1932x1916:
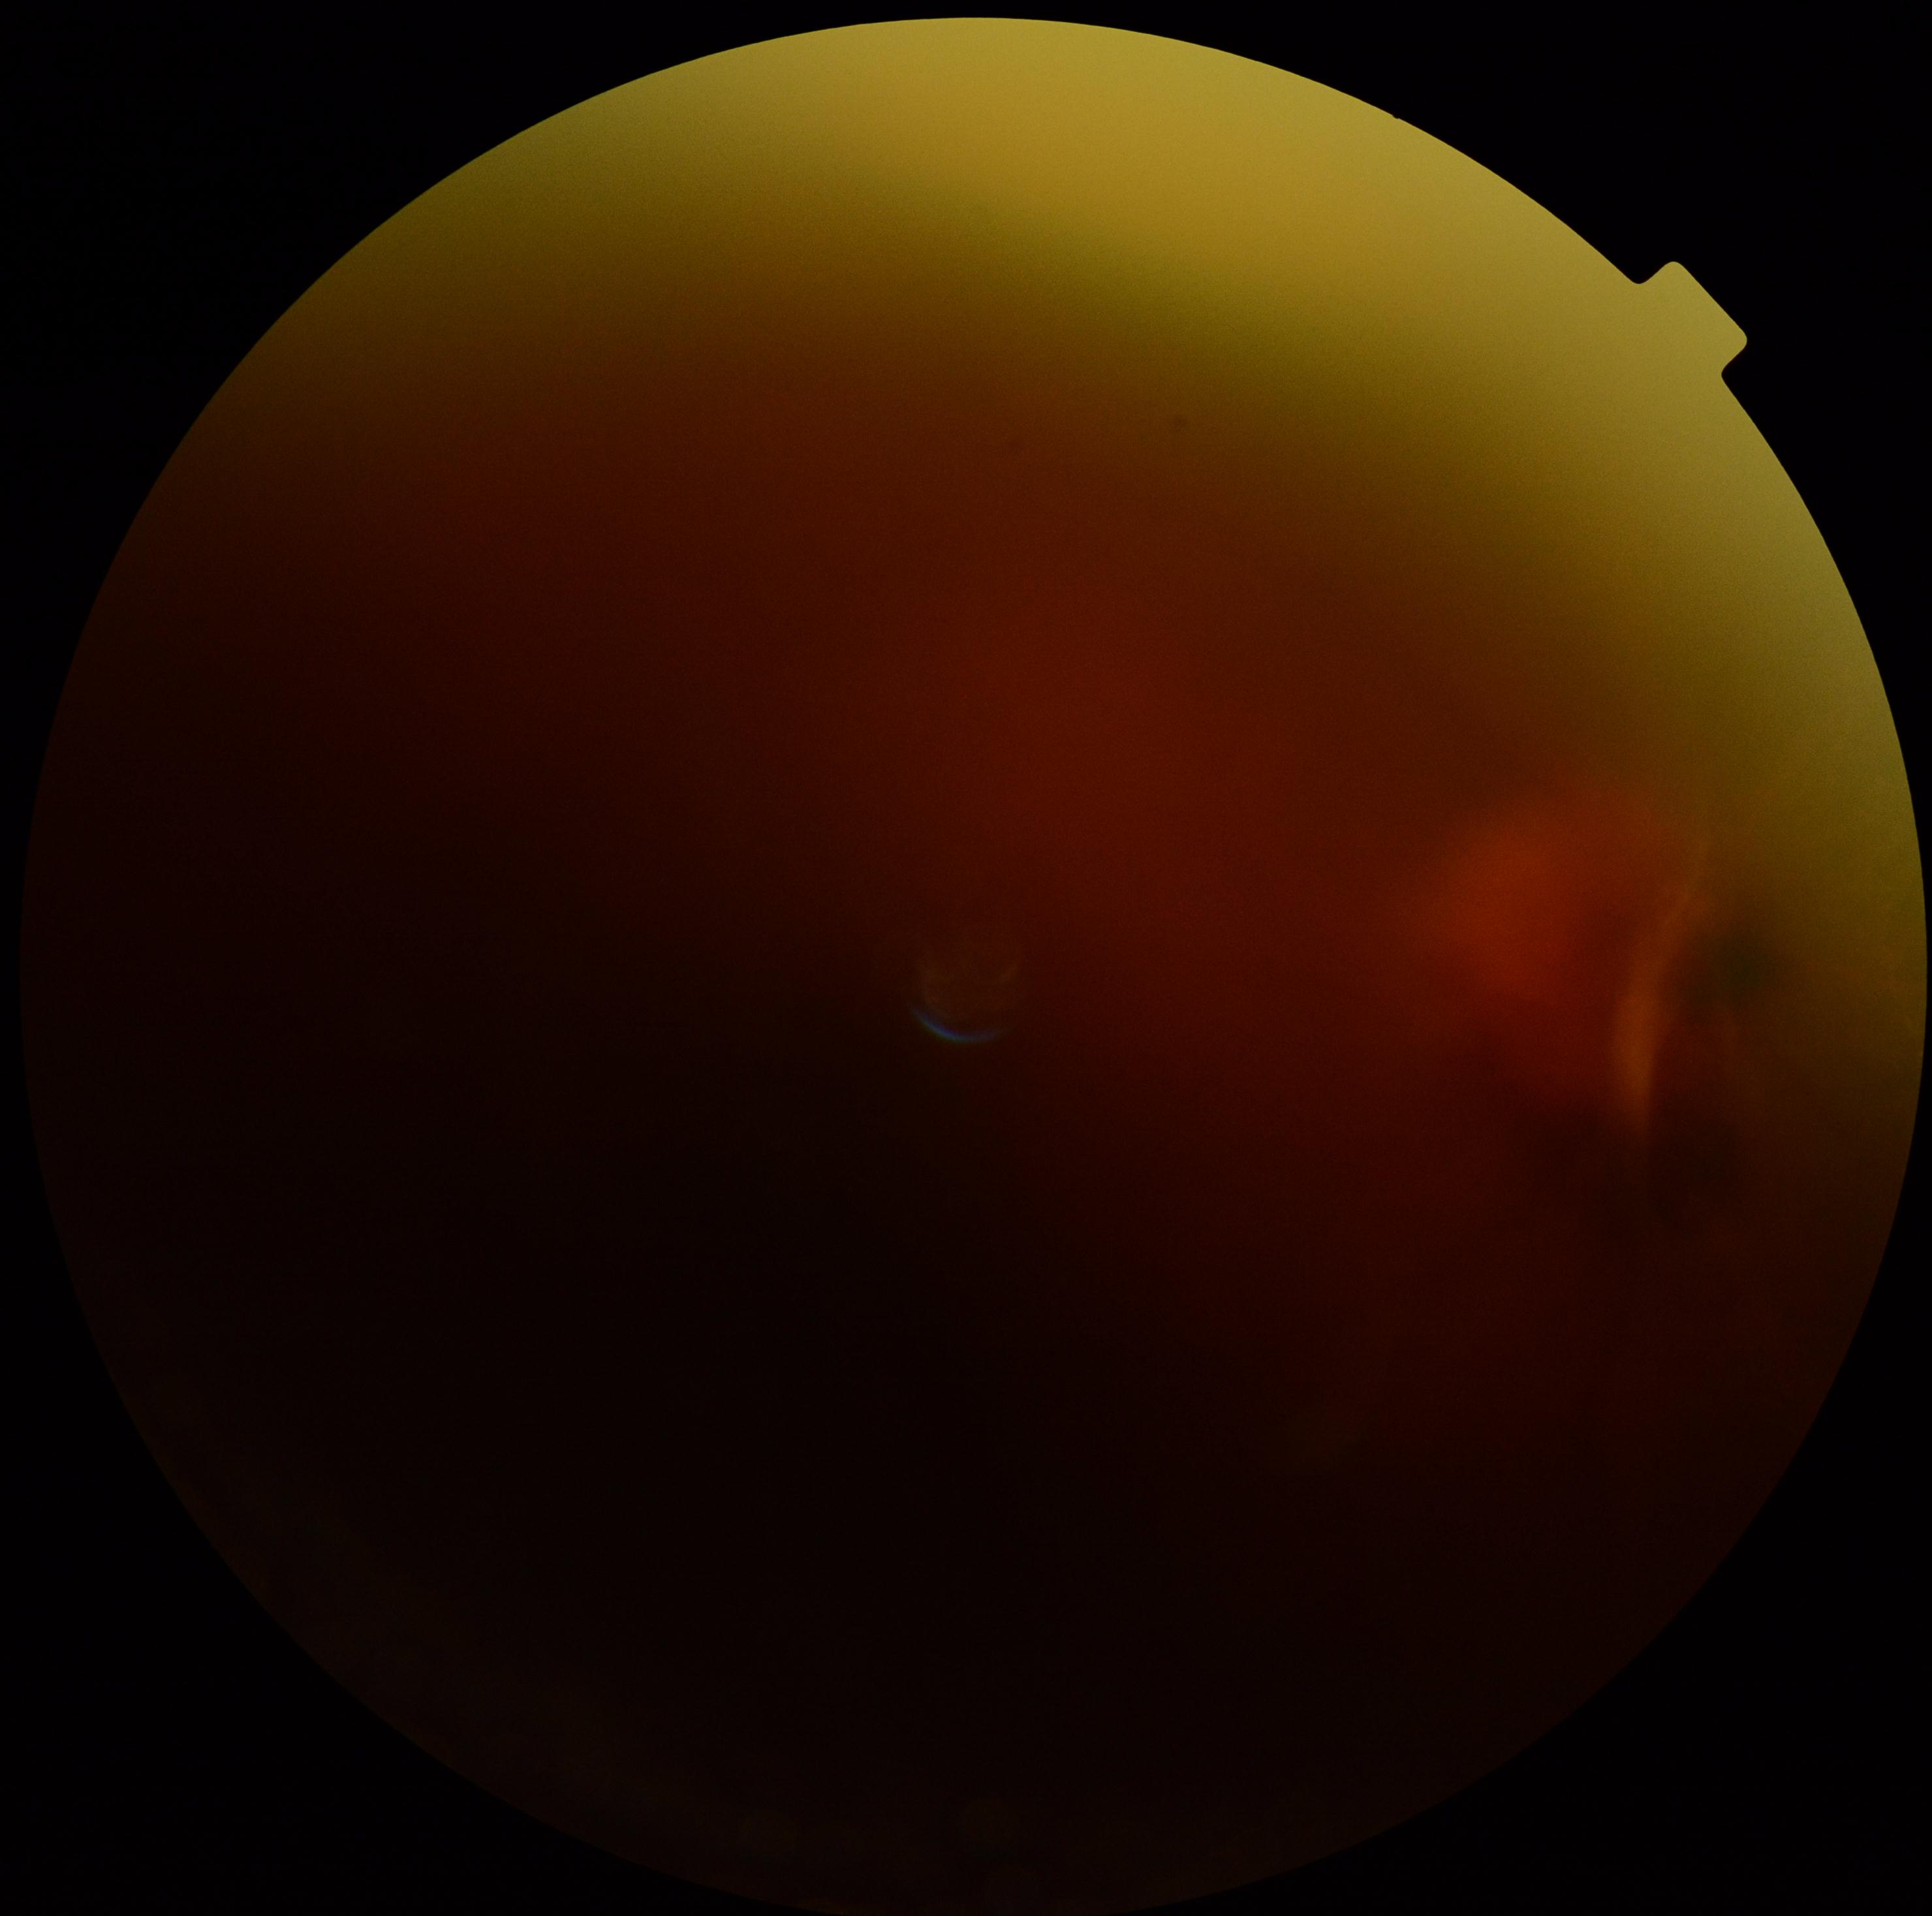

DR stage@grade 4 (PDR).